RetCam wide-field infant fundus image. Acquired on the Clarity RetCam 3. 640 x 480 pixels:
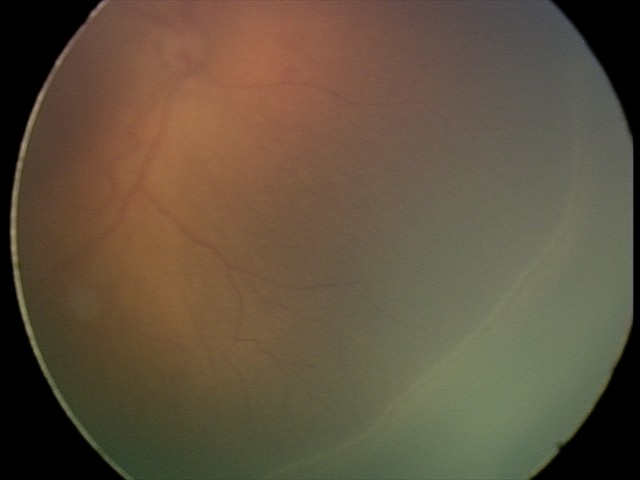 Without plus disease. Screening examination consistent with retinopathy of prematurity (ROP) stage 2.